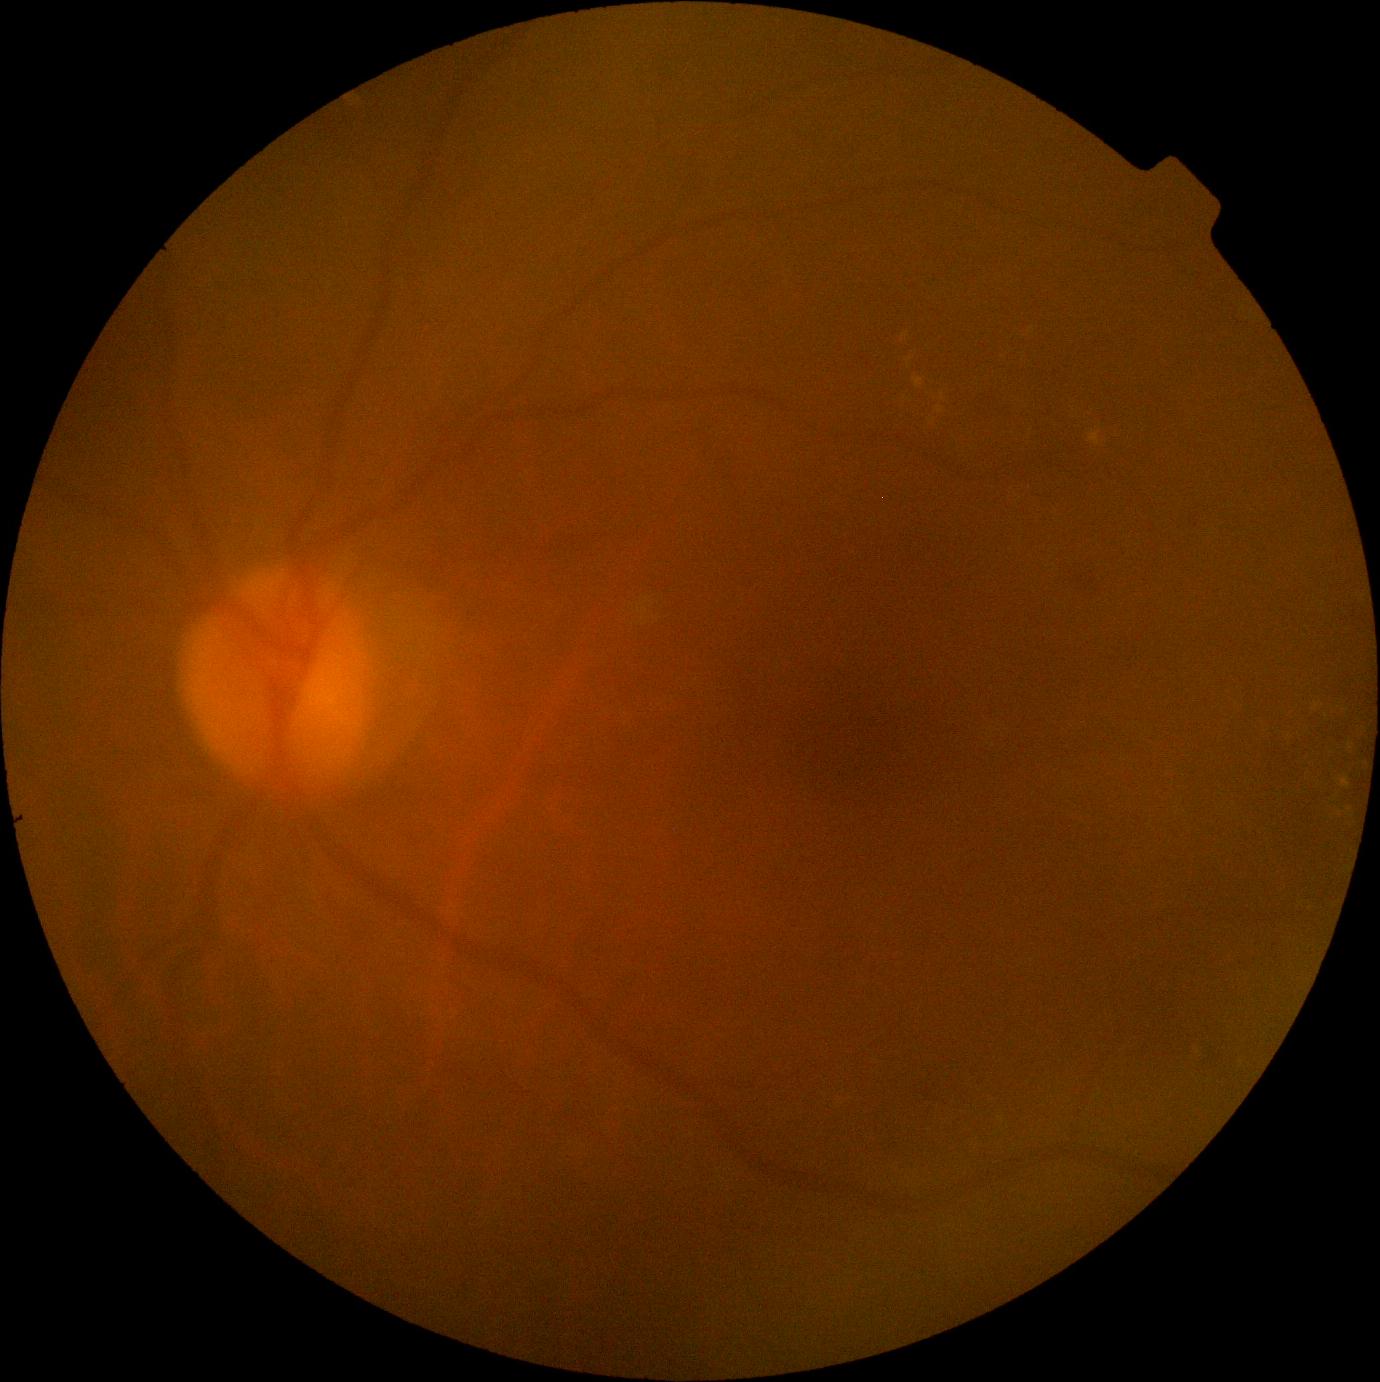 {"dr_grade": "grade 2"}